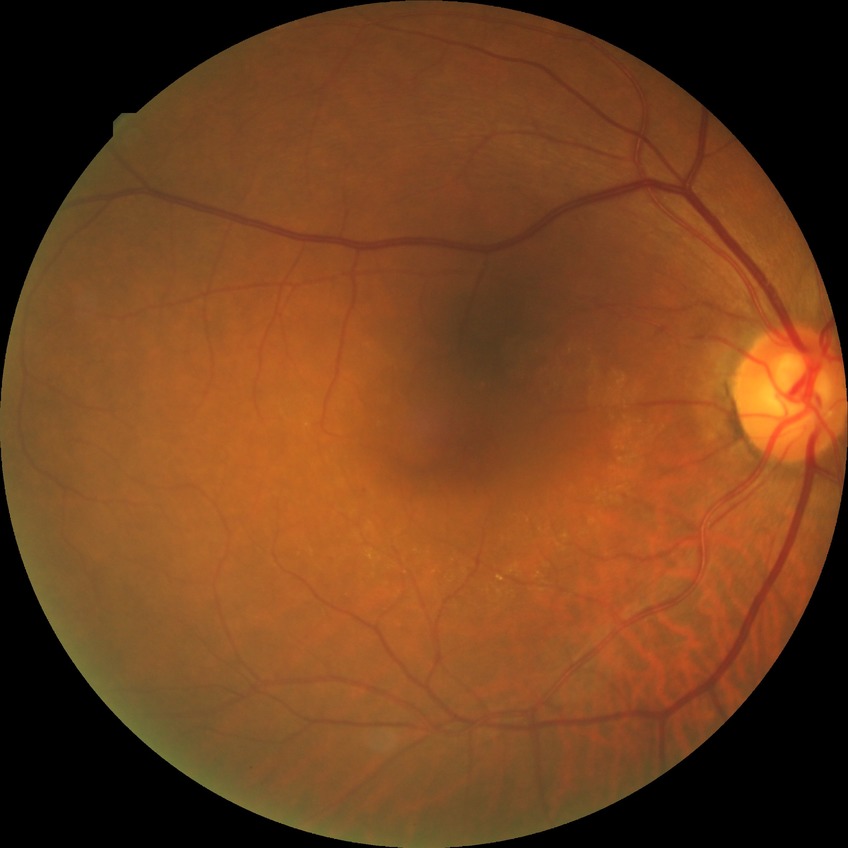

davis_grade: simple diabetic retinopathy